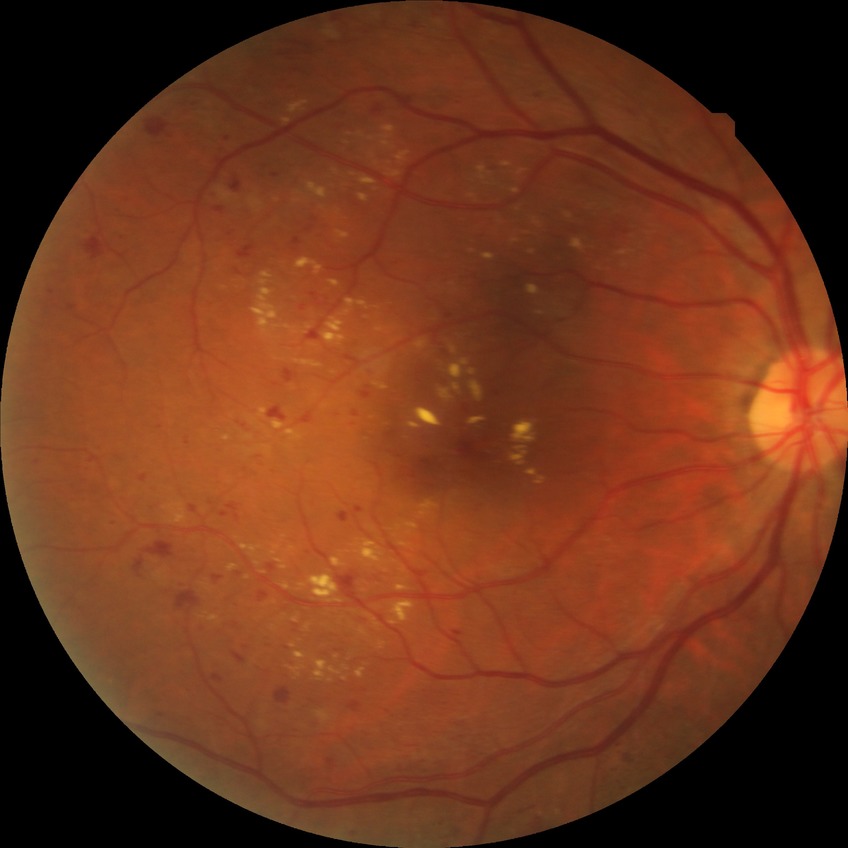

DR class@non-proliferative diabetic retinopathy, Davis grade@SDR.